Optic disc-centered; non-mydriatic acquisition; 30° FOV; fundus photo: 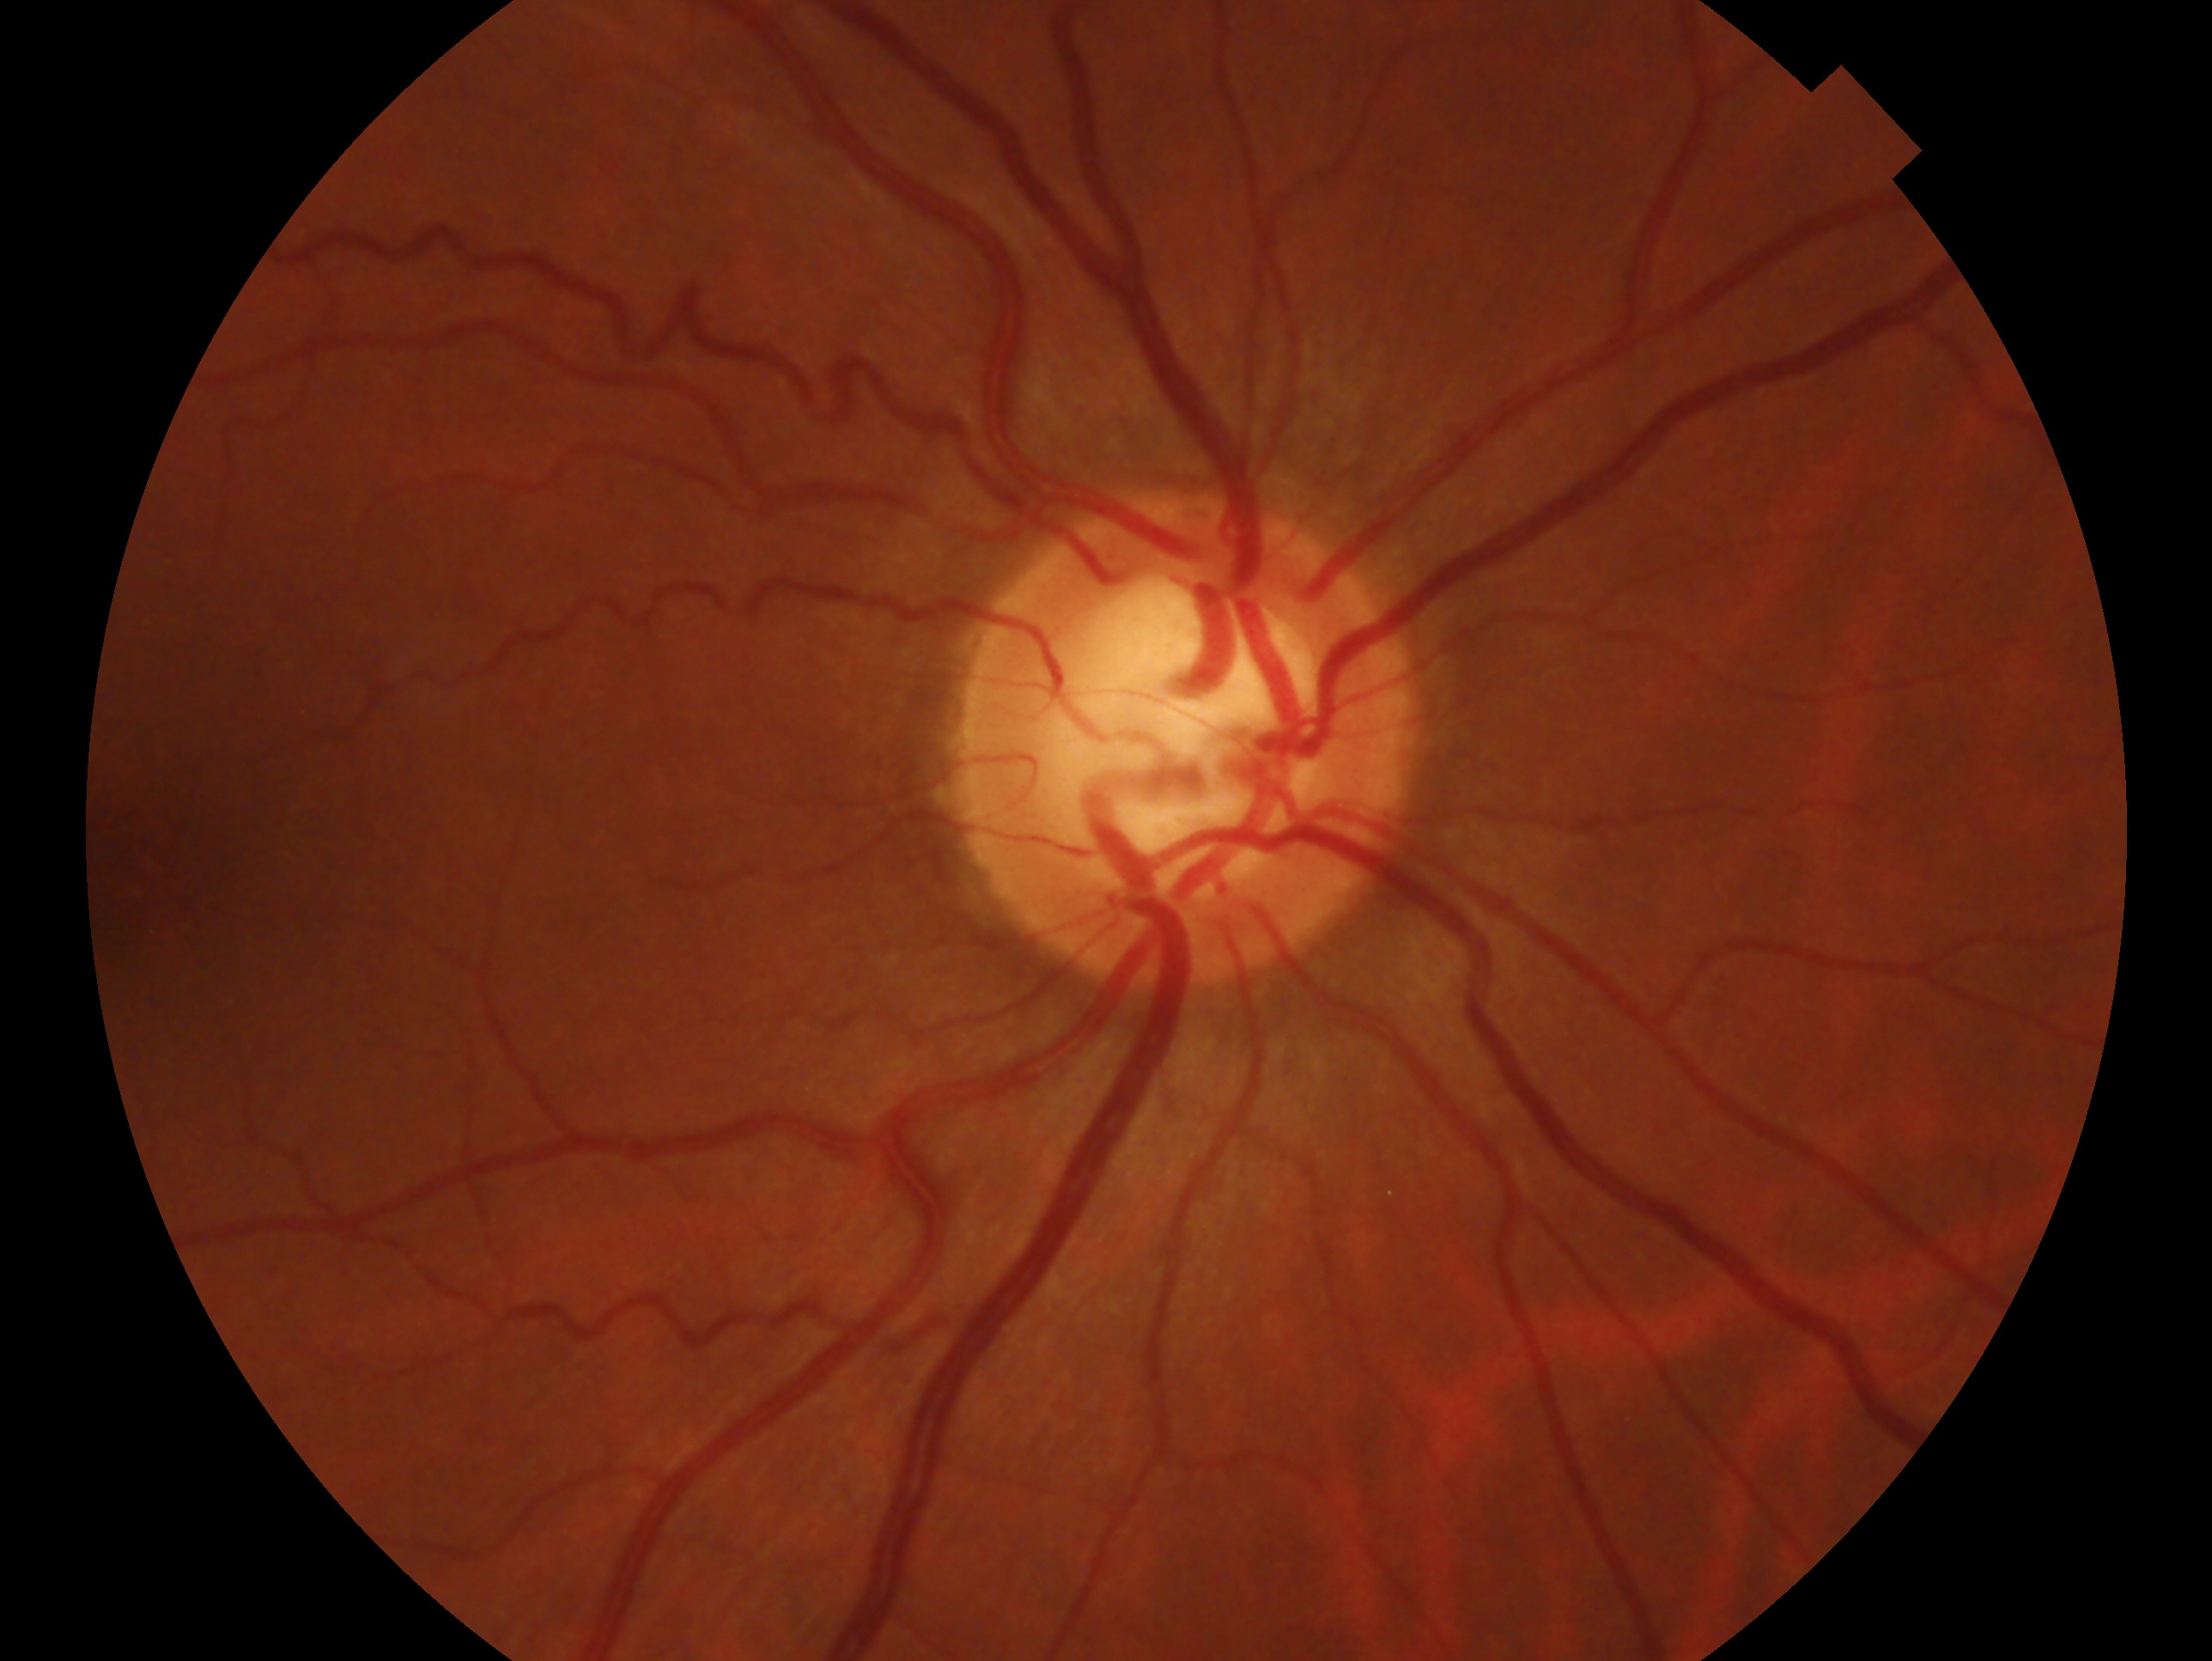 Clinical classification: no evidence of glaucoma. Imaged eye: right.